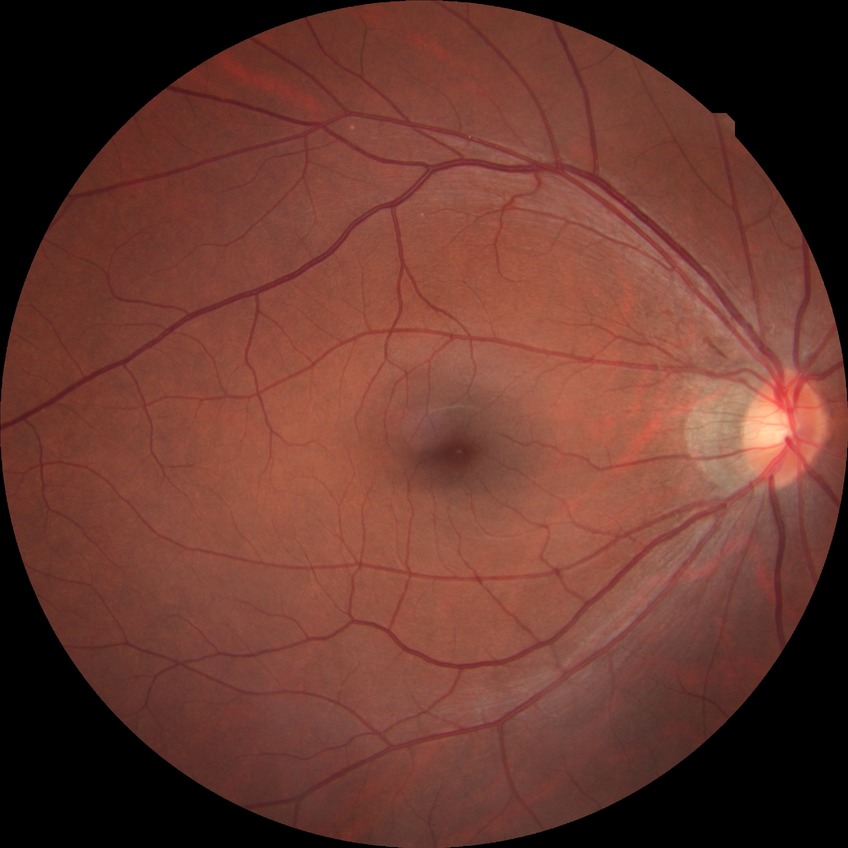

diabetic retinopathy (DR) = NDR (no diabetic retinopathy)